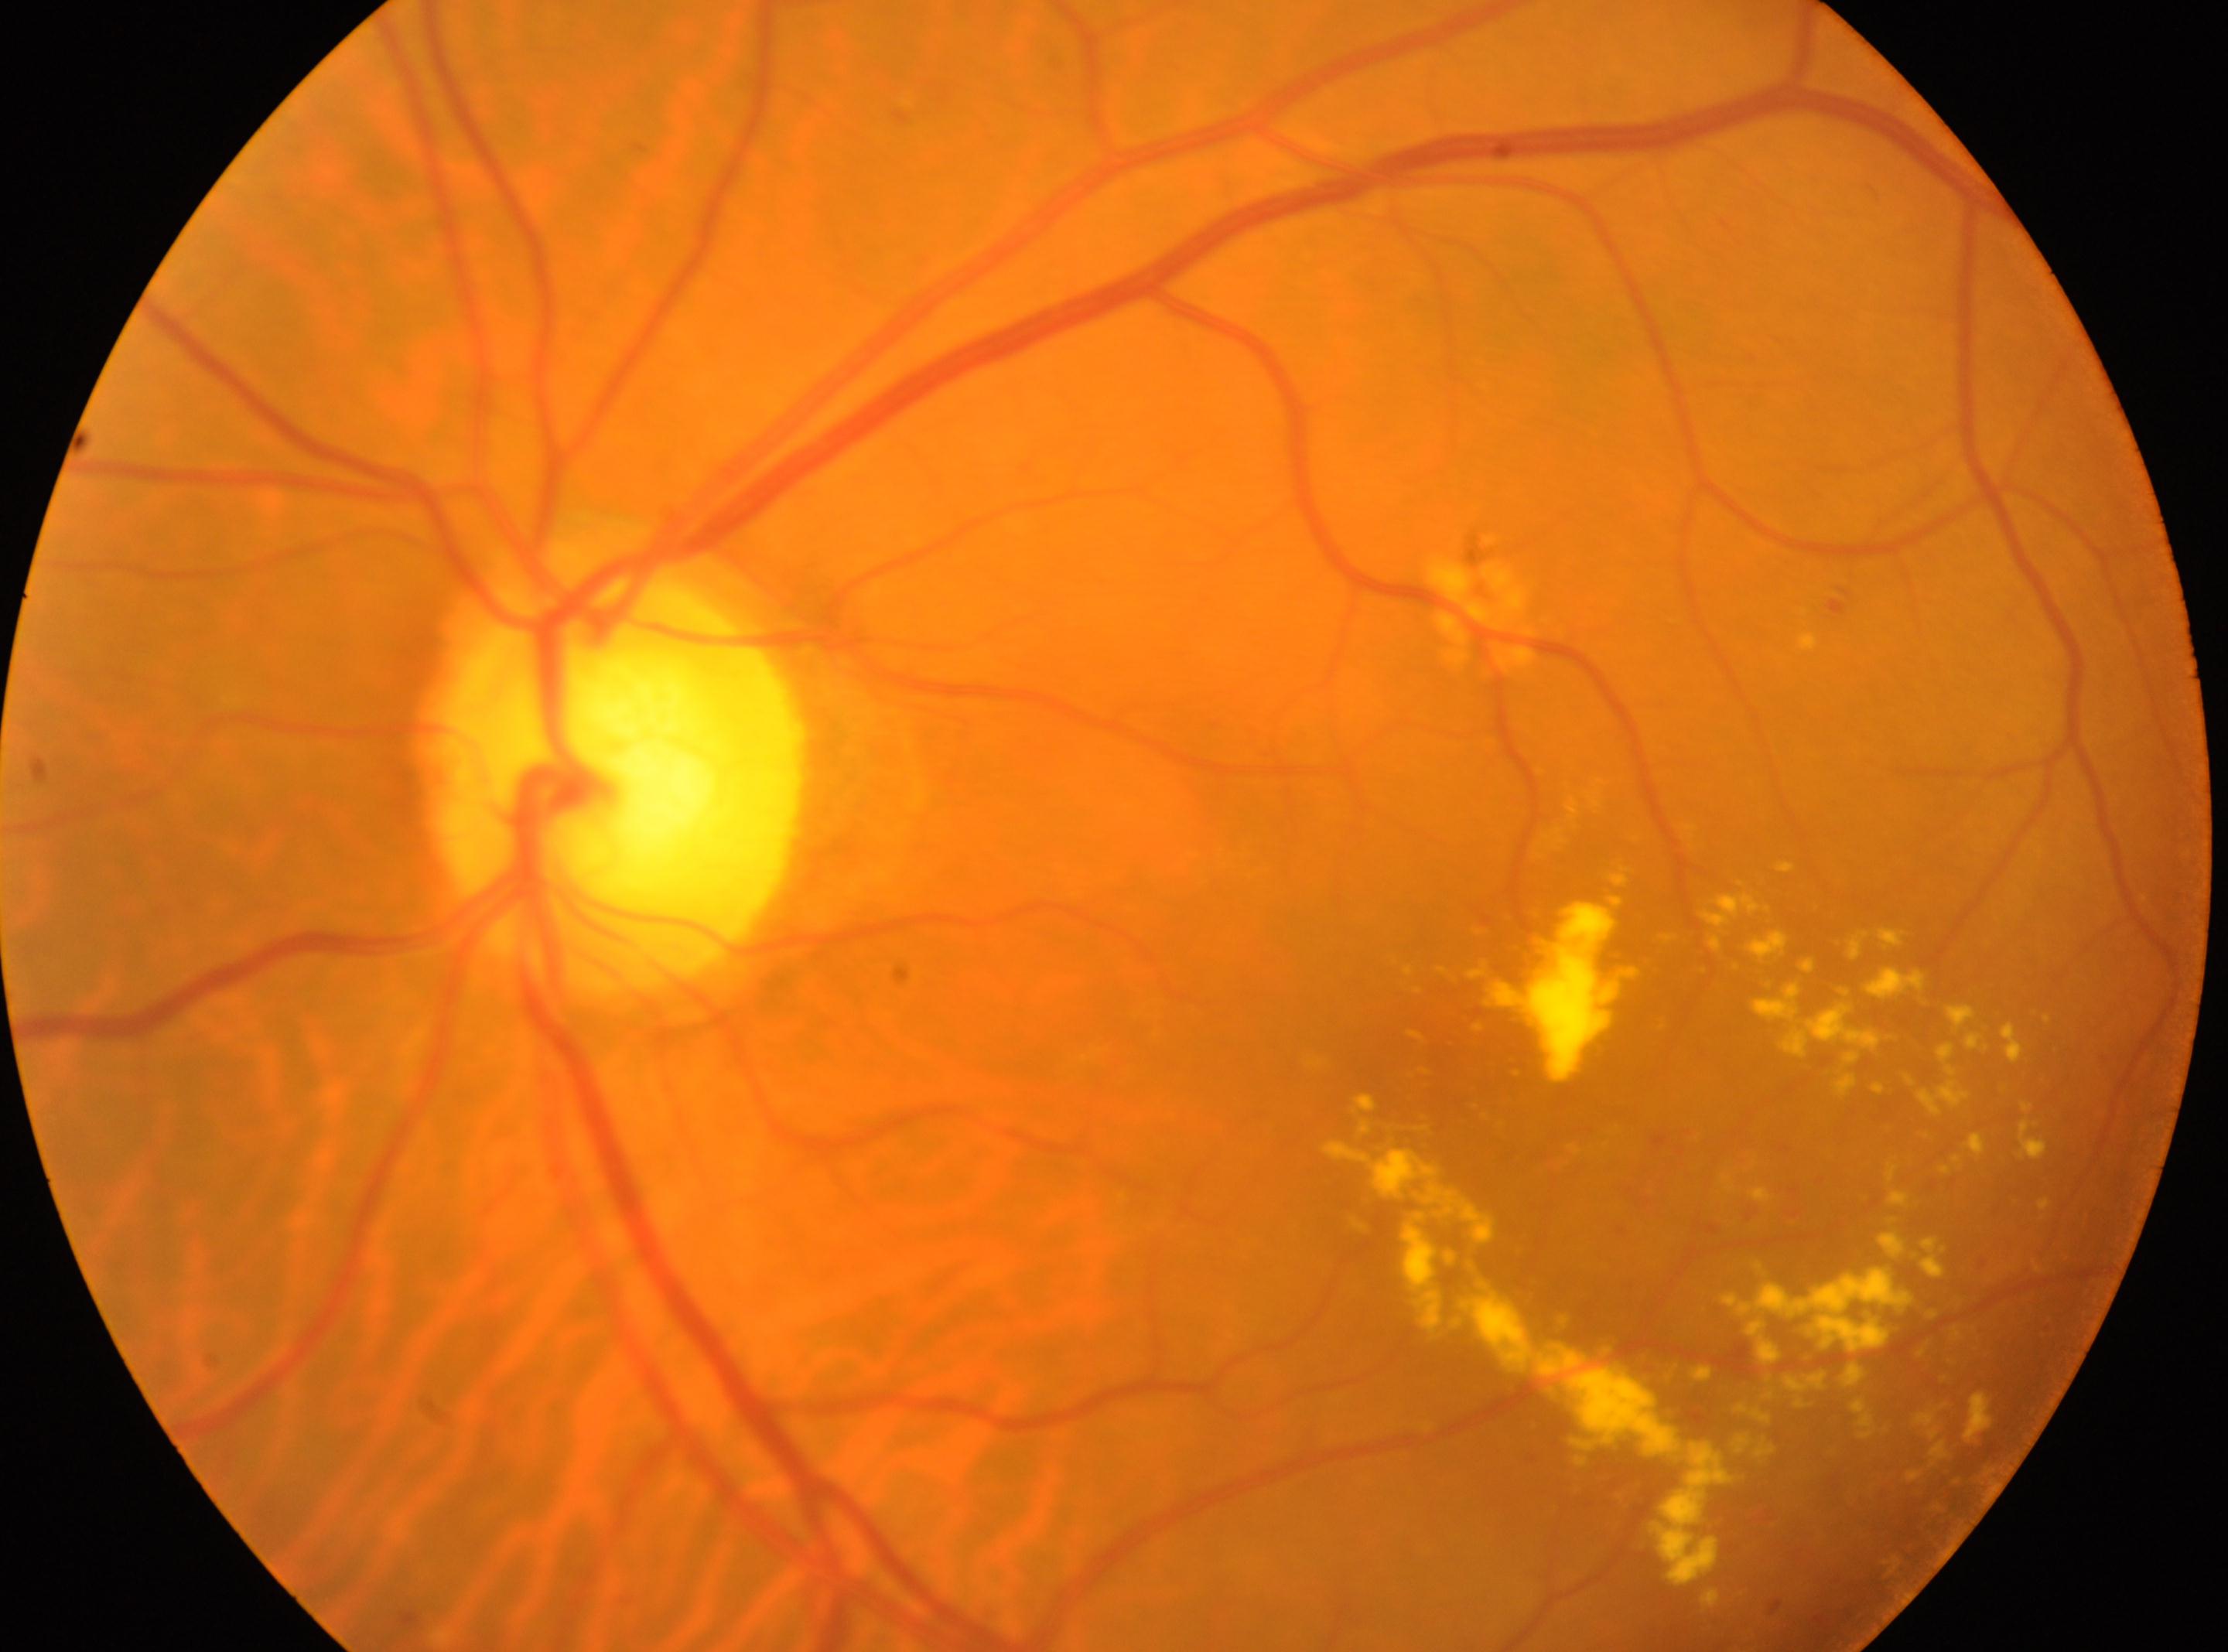

Q: Which eye is imaged?
A: left eye
Q: DR stage?
A: moderate NPDR (grade 2)
Q: Locate the optic disc.
A: x=619, y=787
Q: Fovea center?
A: x=1448, y=1039